640x480. RetCam wide-field infant fundus image.
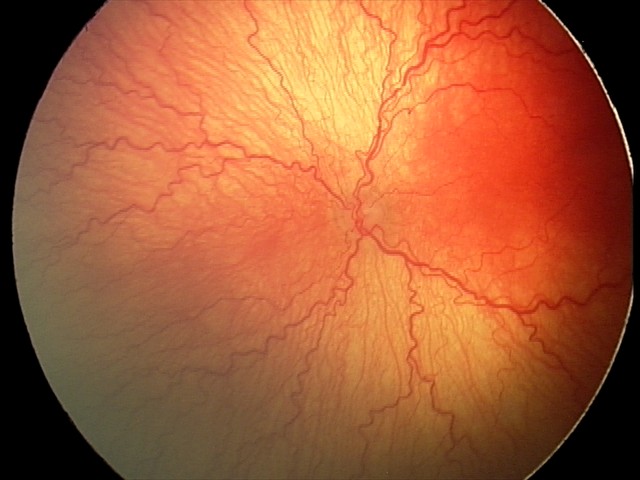 Q: Plus disease status?
A: plus disease
Q: What is the screening diagnosis?
A: aggressive retinopathy of prematurity — rapidly progressive severe ROP with prominent plus disease, often without classic stage progression